Retinal fundus photograph: 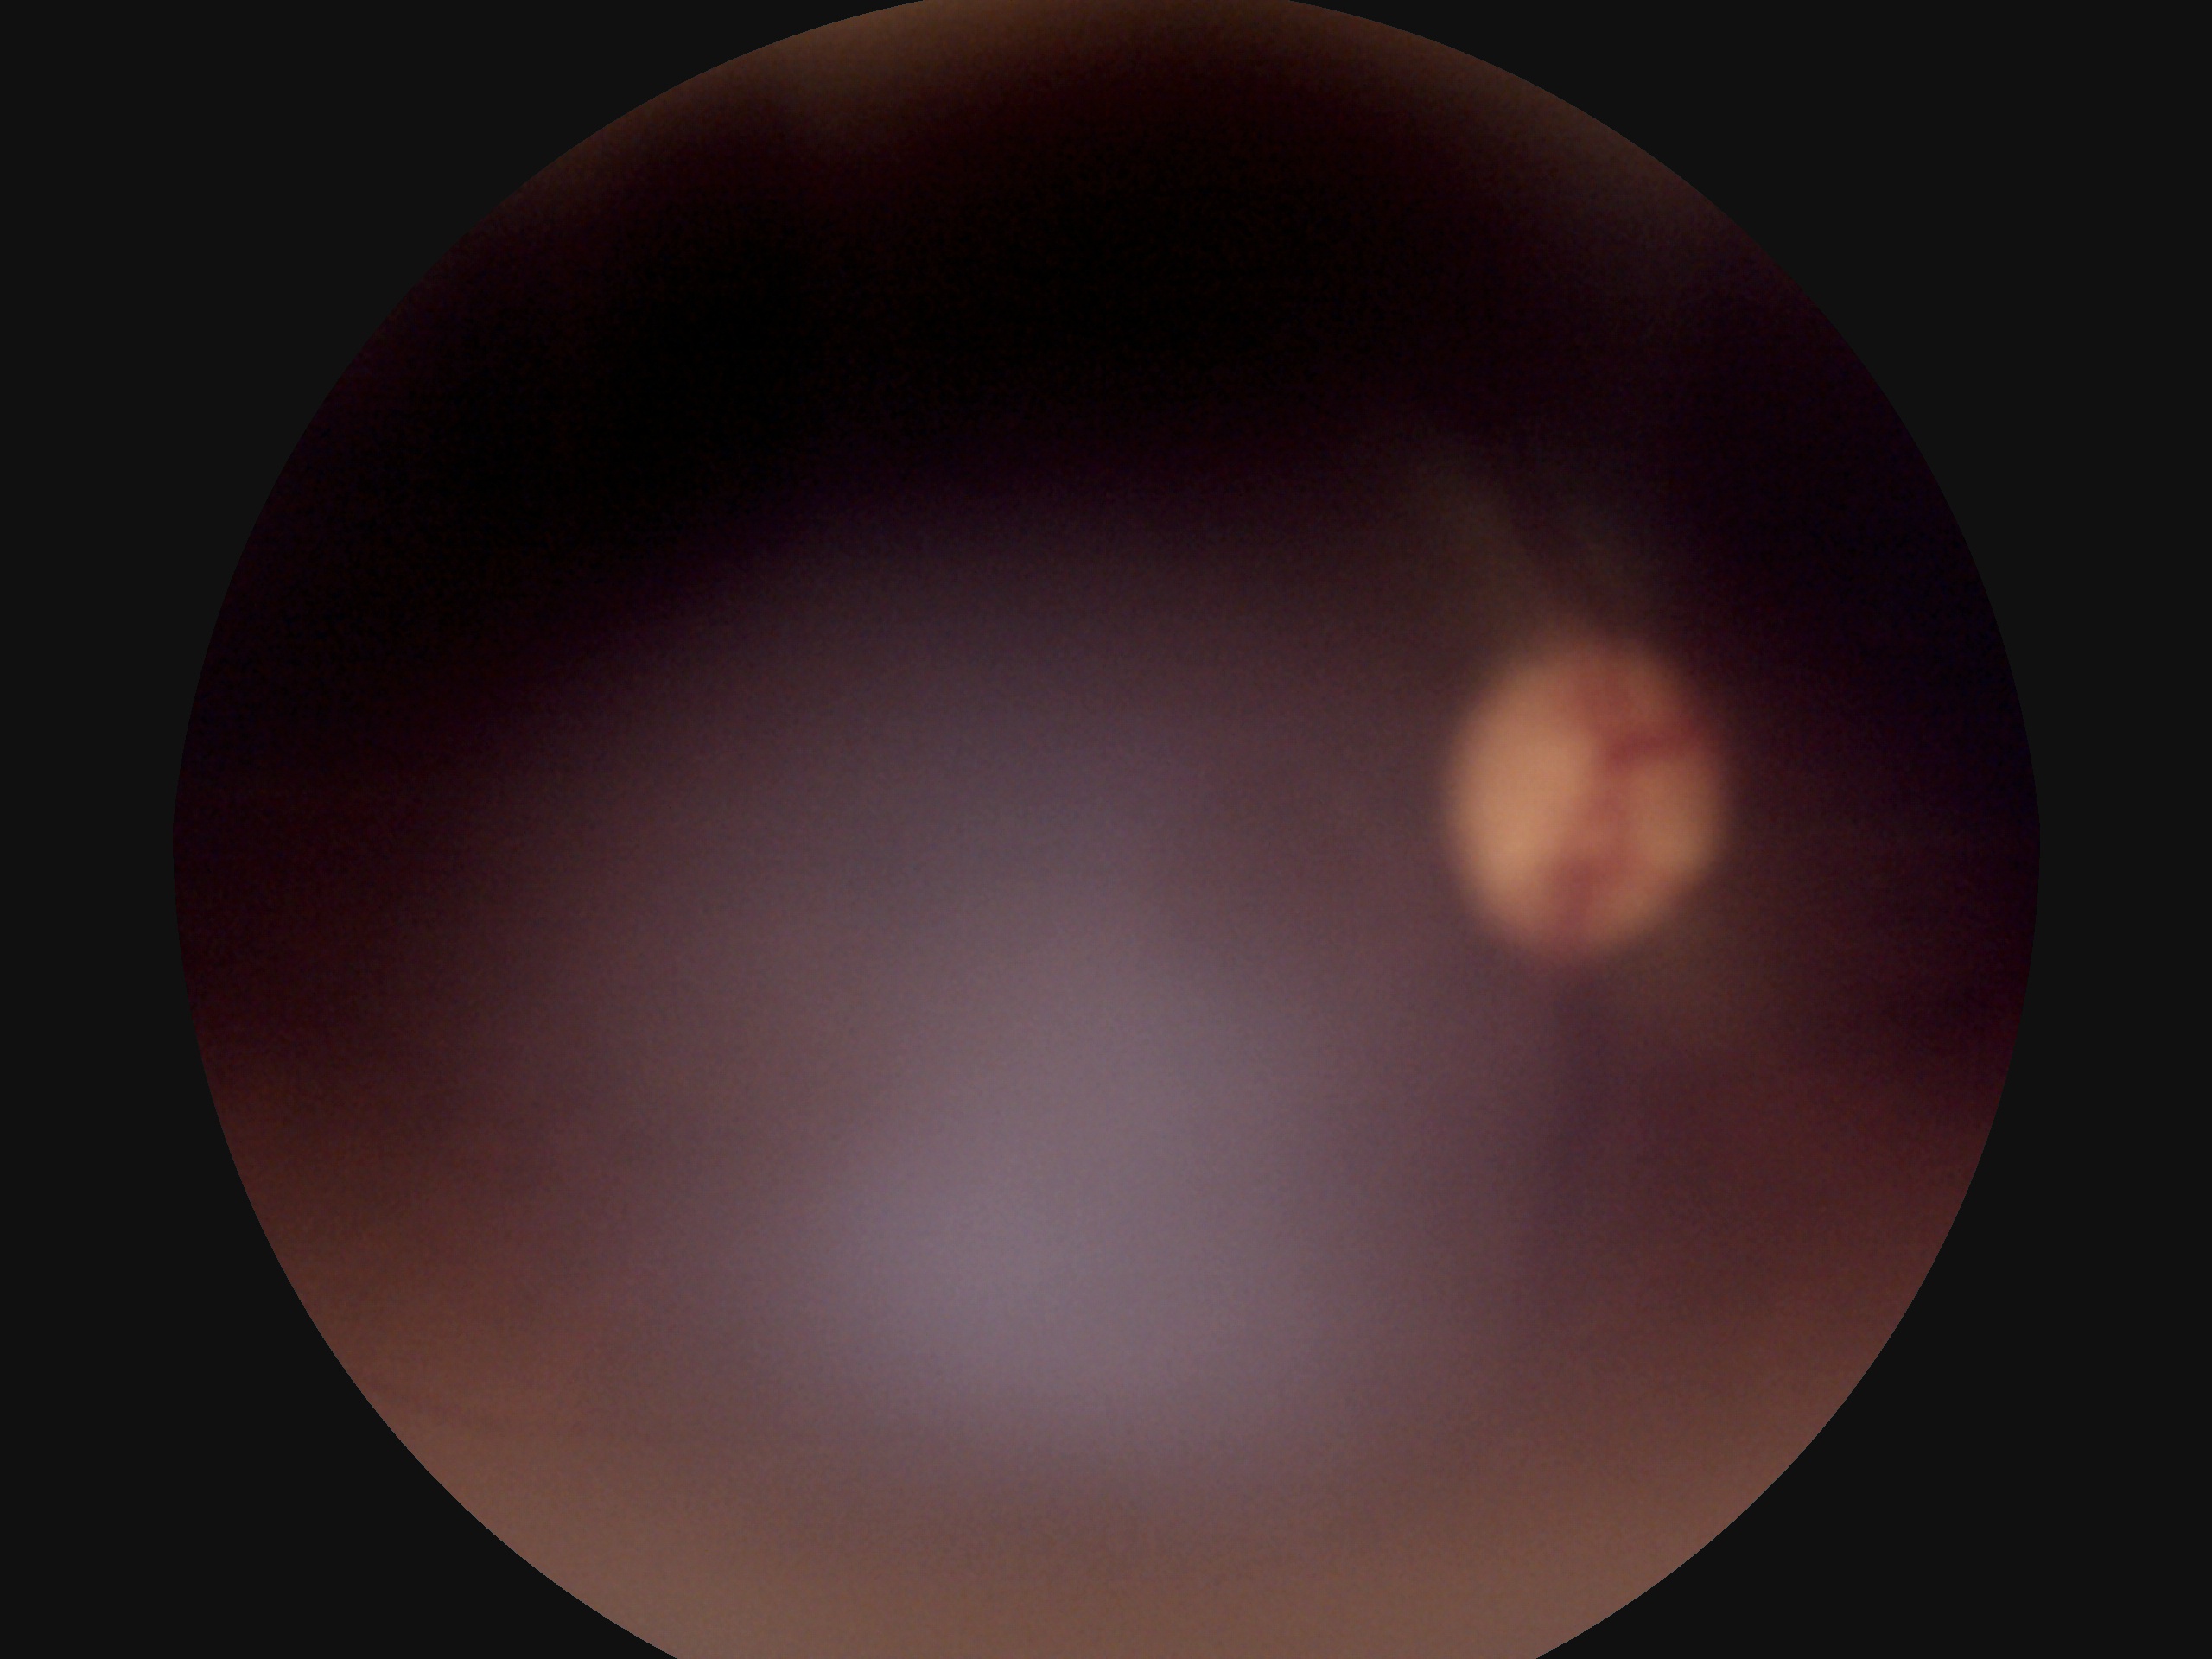

{
  "dr_grade": "ungradable",
  "quality": "below grading threshold"
}